Fundus photo · camera: NIDEK AFC-230 · FOV: 45 degrees.
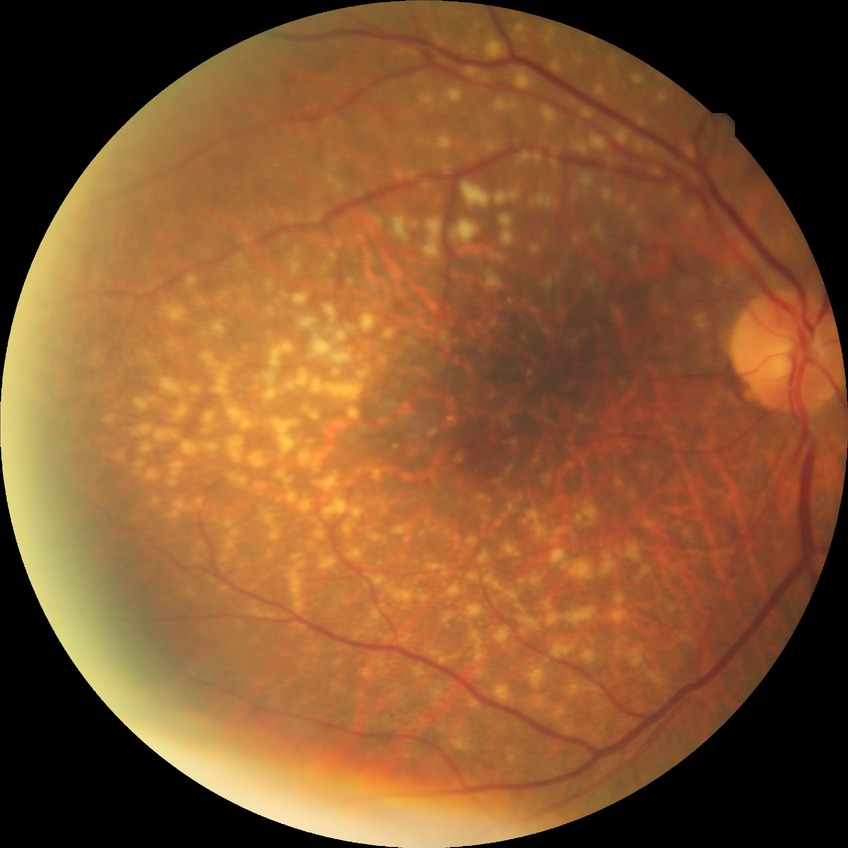

Davis DR grade: NDR.